Wide-field contact fundus photograph of an infant:
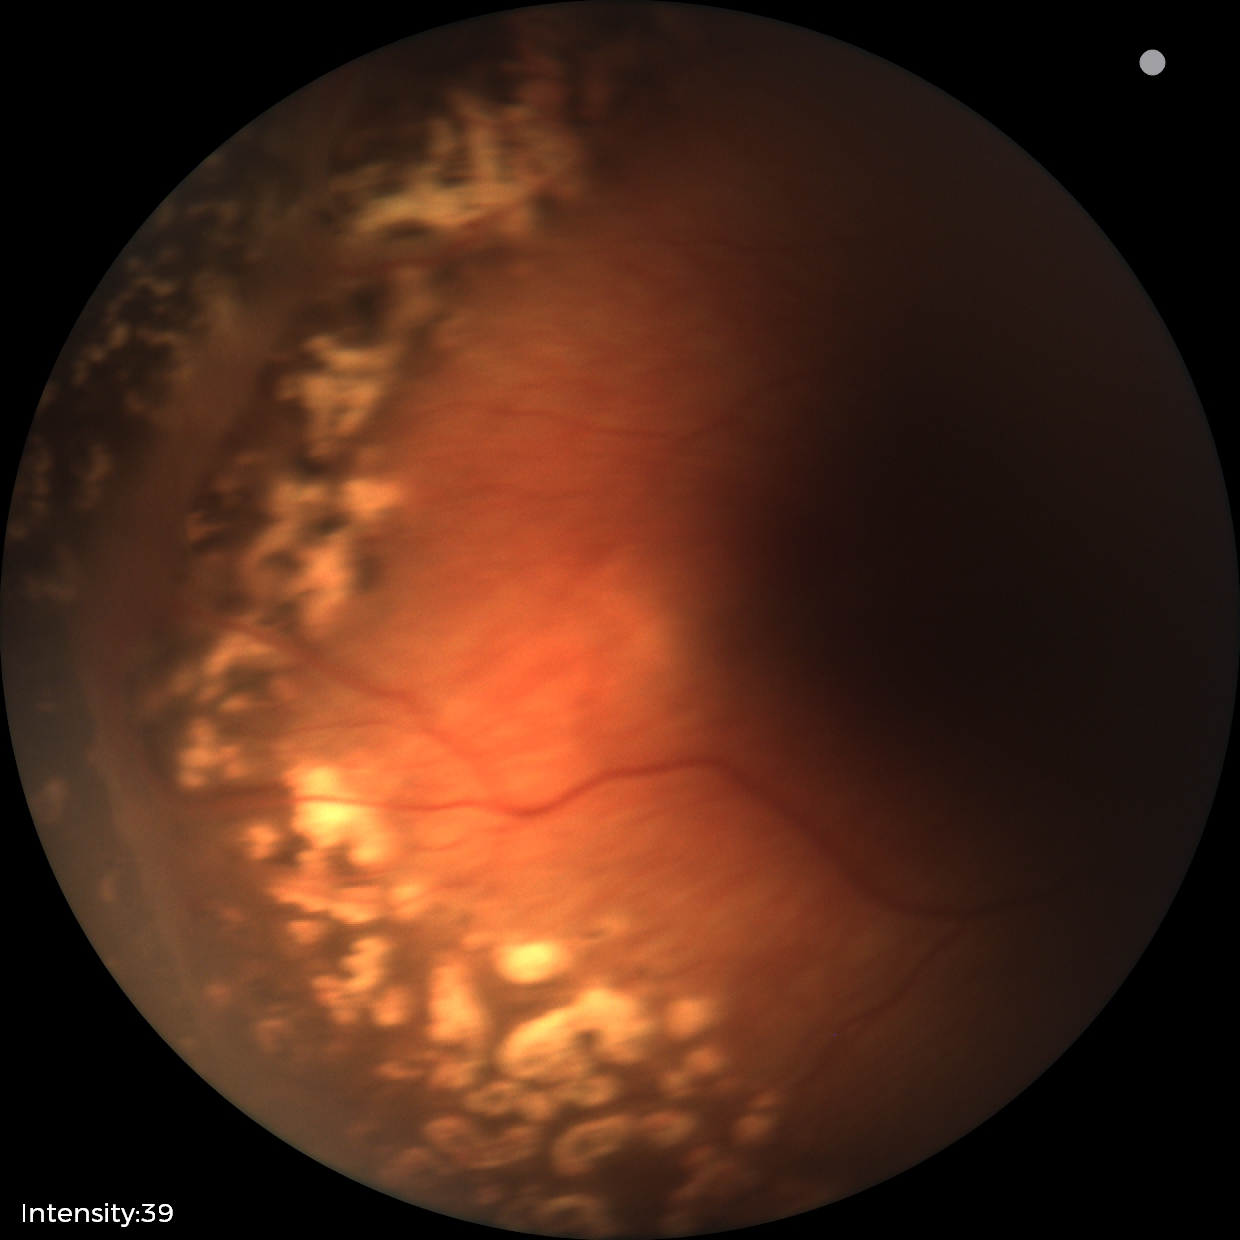

Examination diagnosed as status post ROP.